Image size 2352x1568, 45° FOV: 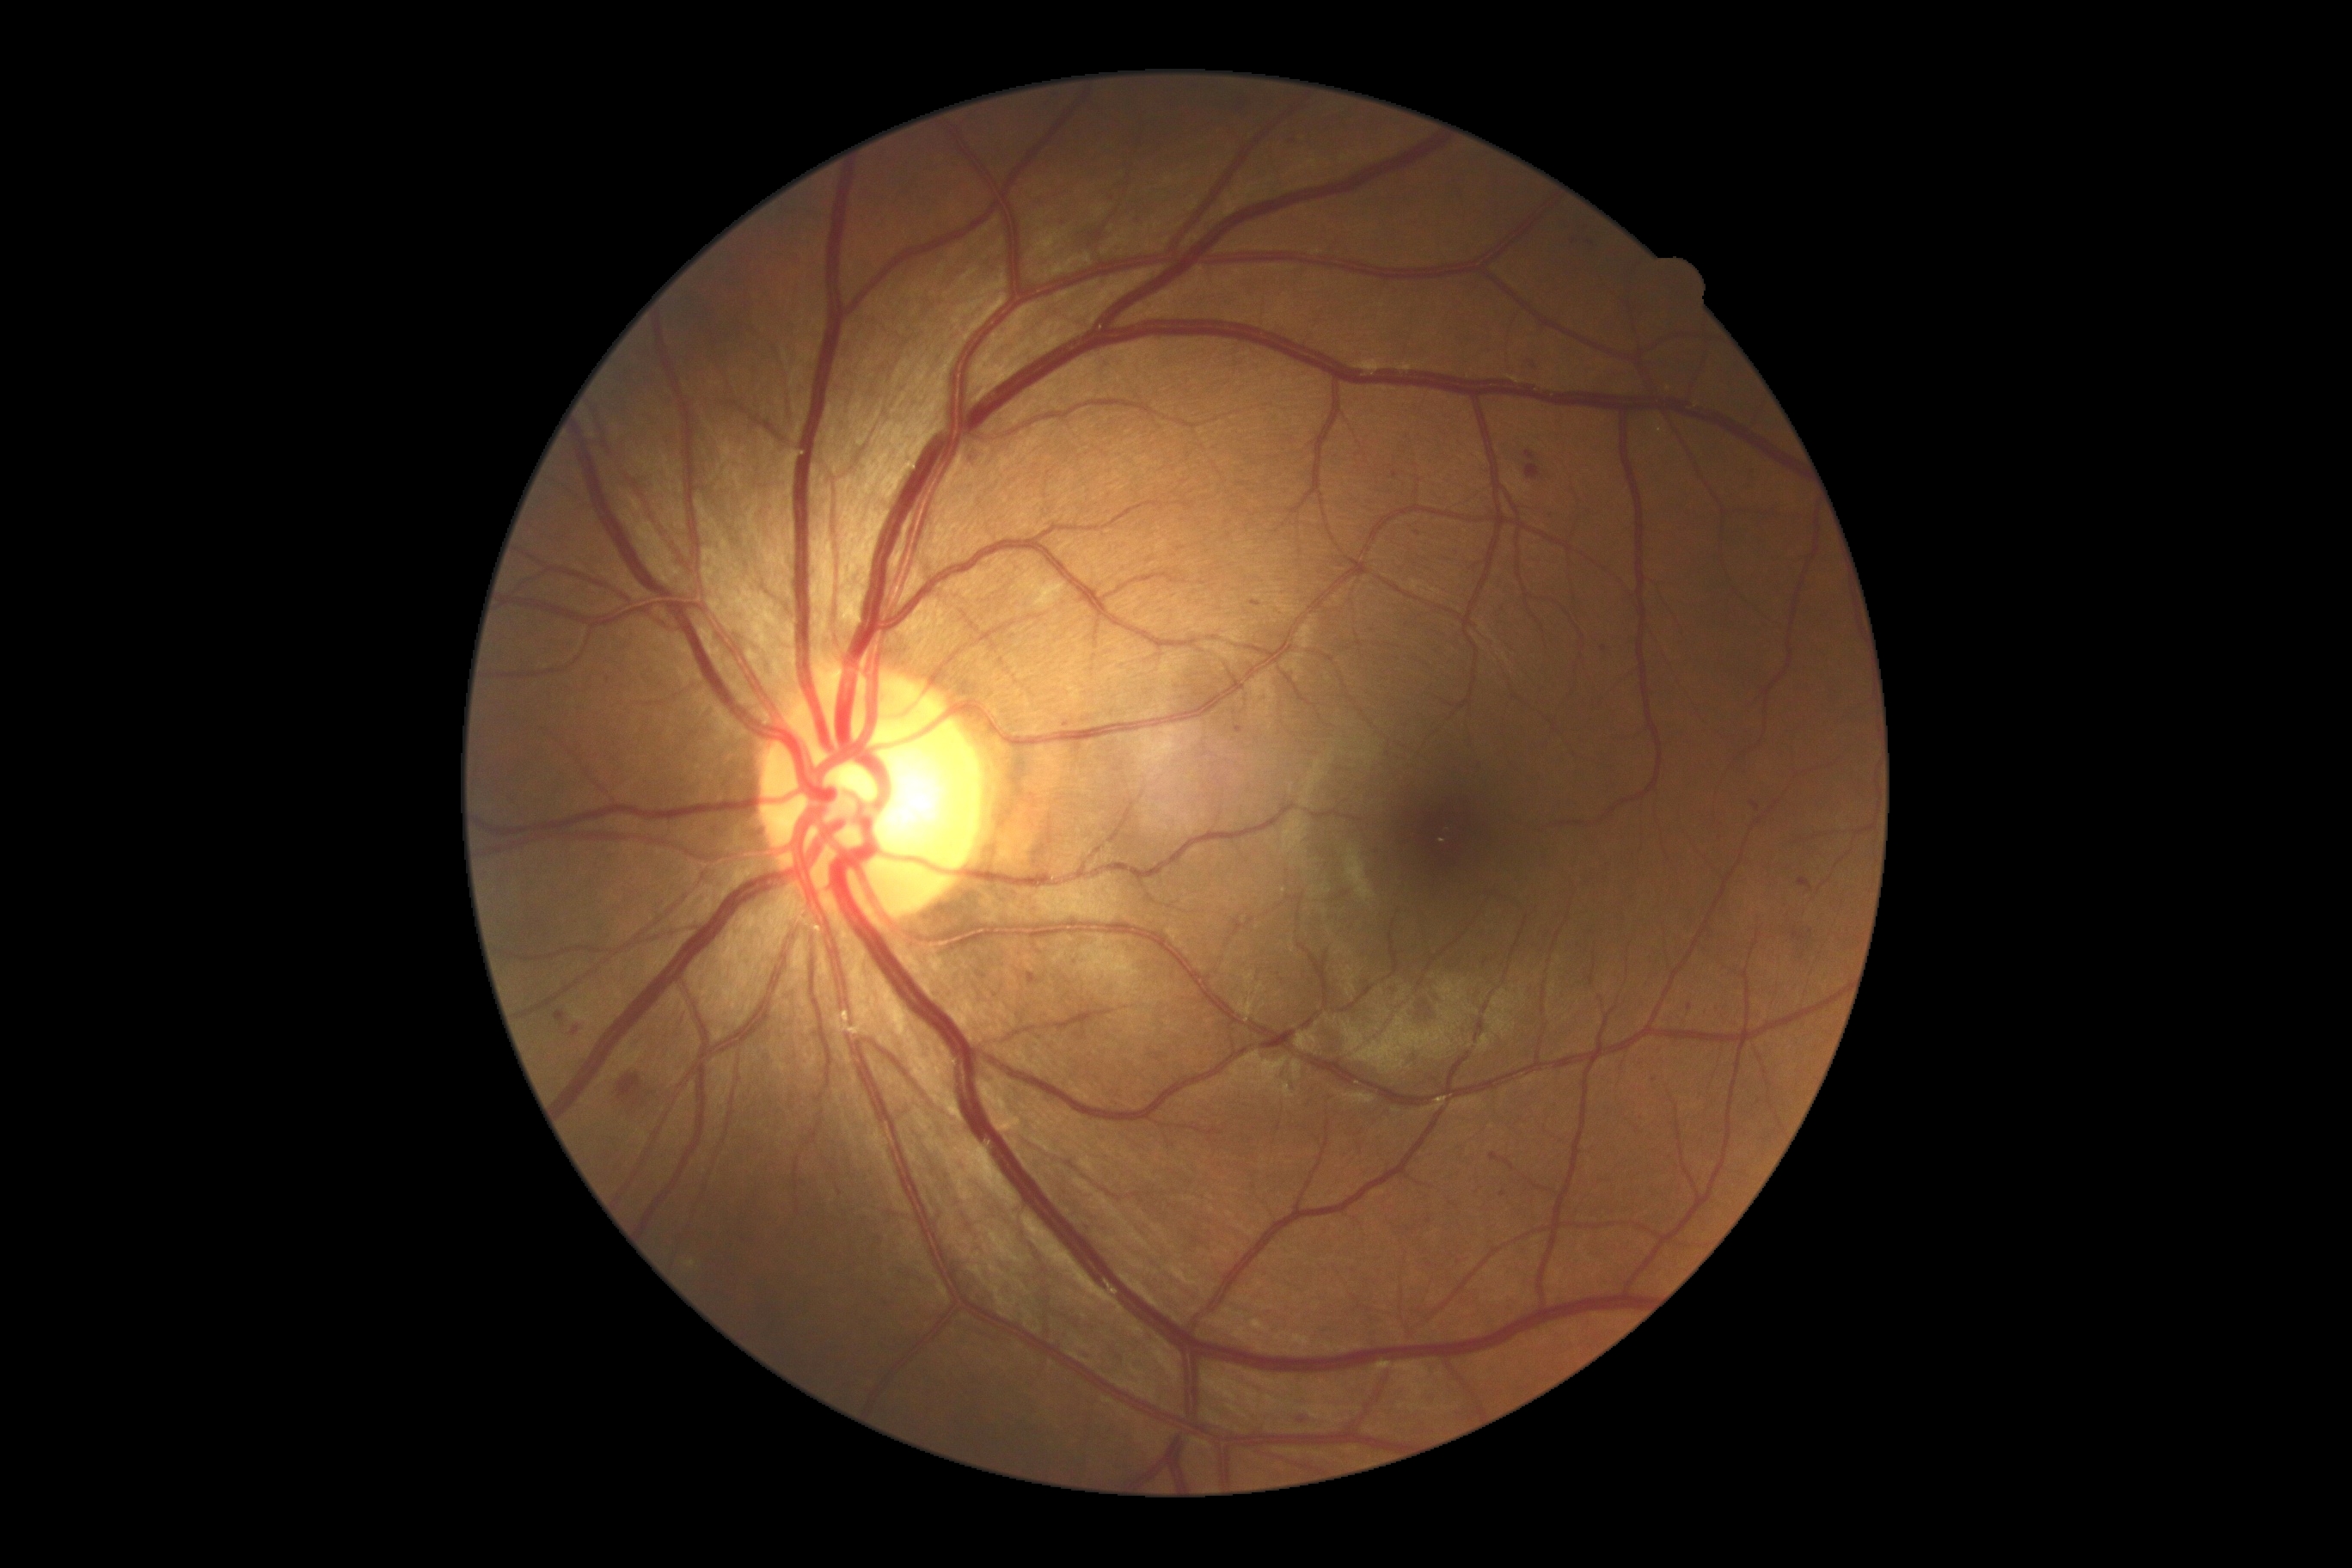
DR severity is grade 2 (moderate NPDR)
Representative lesions:
MAs (subset) = [x1=1526, y1=451, x2=1536, y2=462]; [x1=1027, y1=972, x2=1041, y2=986]; [x1=1055, y1=219, x2=1065, y2=226]; [x1=1301, y1=1416, x2=1309, y2=1423]; [x1=1526, y1=465, x2=1541, y2=481]; [x1=1235, y1=726, x2=1244, y2=735]
MAs (small, approximate centers) near 1418/534; 1144/219; 1503/1194; 1113/198